No pharmacologic dilation · image size 848x848 · retinal fundus photograph: 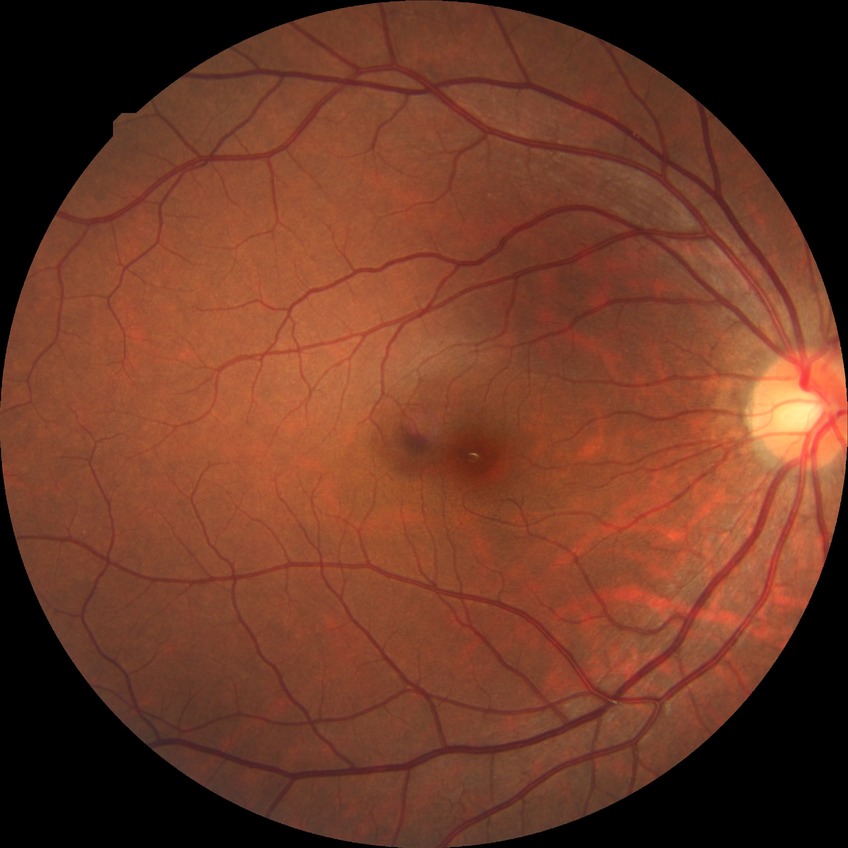
- diabetic retinopathy (DR) — no diabetic retinopathy (NDR)